200° FOV:
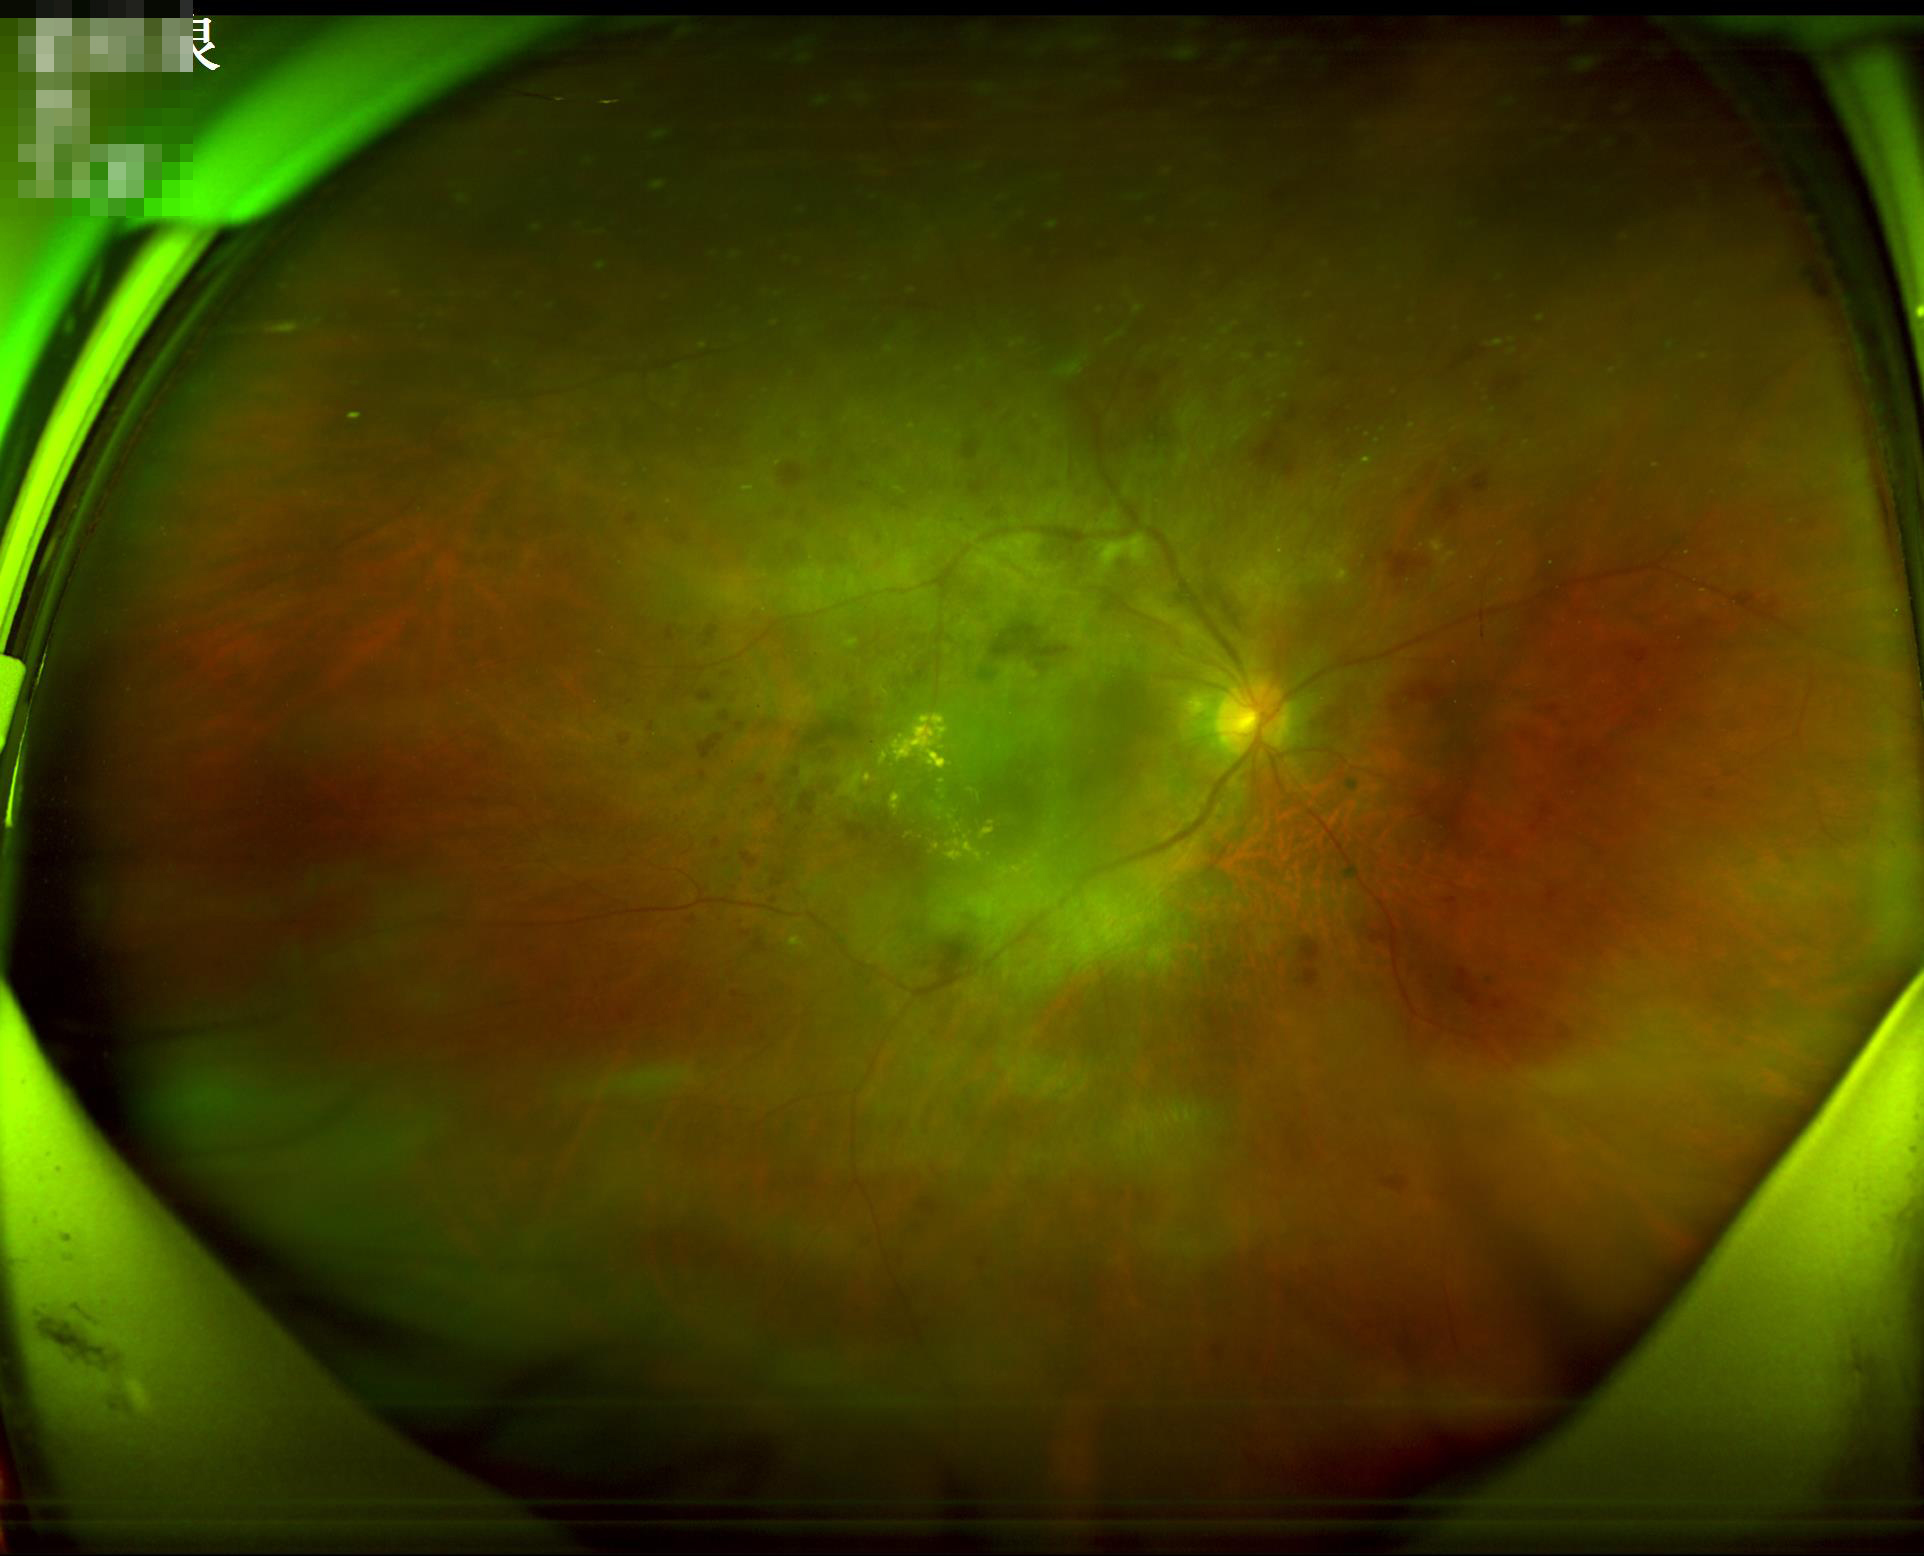 Poor illumination with uneven exposure. Reduced sharpness with visible blur. Vessels and details are readily distinguishable. Overall quality is poor; the image is difficult to grade.